Color fundus photograph:
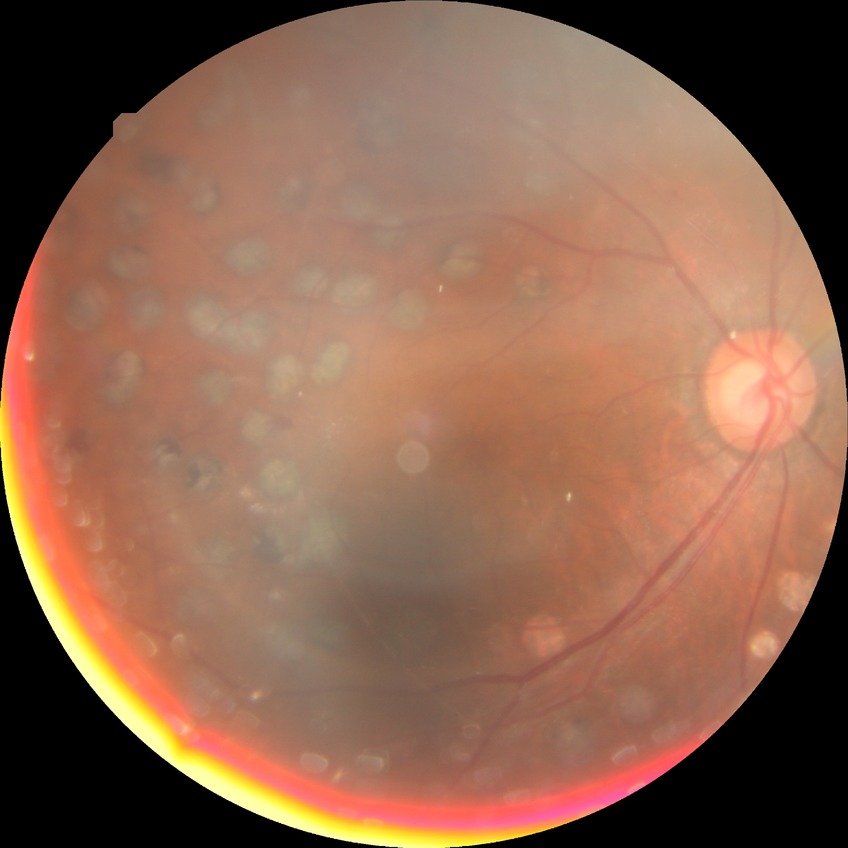 * diabetic retinopathy (DR): proliferative diabetic retinopathy (PDR)